Camera: NIDEK AFC-230. Fundus photo. 45-degree field of view. Nonmydriatic fundus photograph
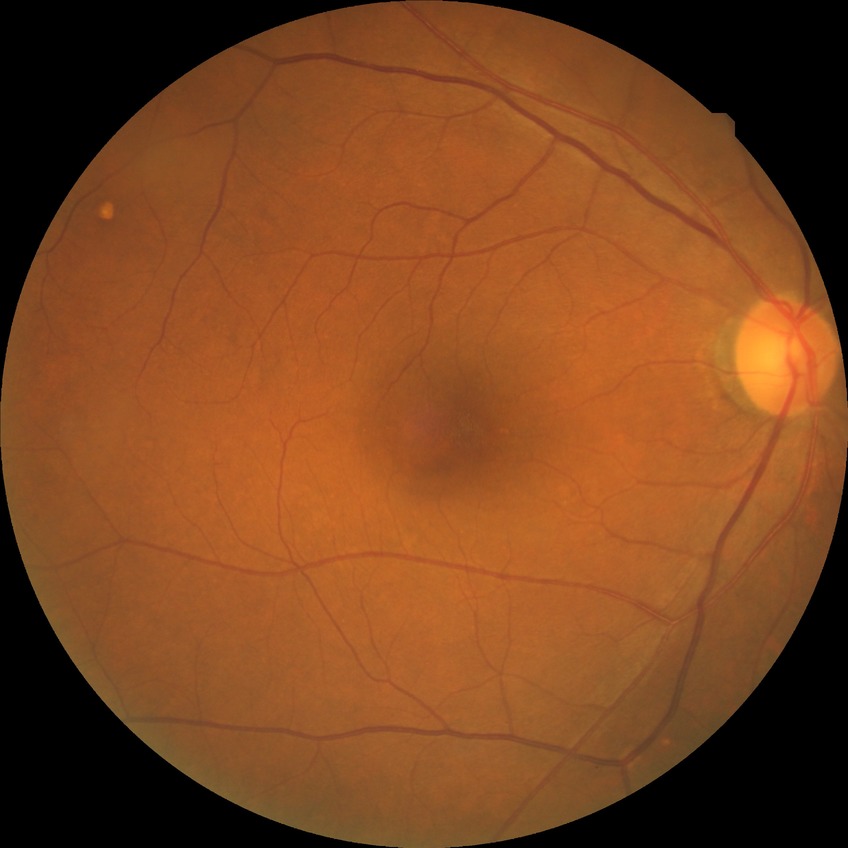 Davis DR grade is NDR.